130° field of view (Natus RetCam Envision). Pediatric retinal photograph (wide-field)
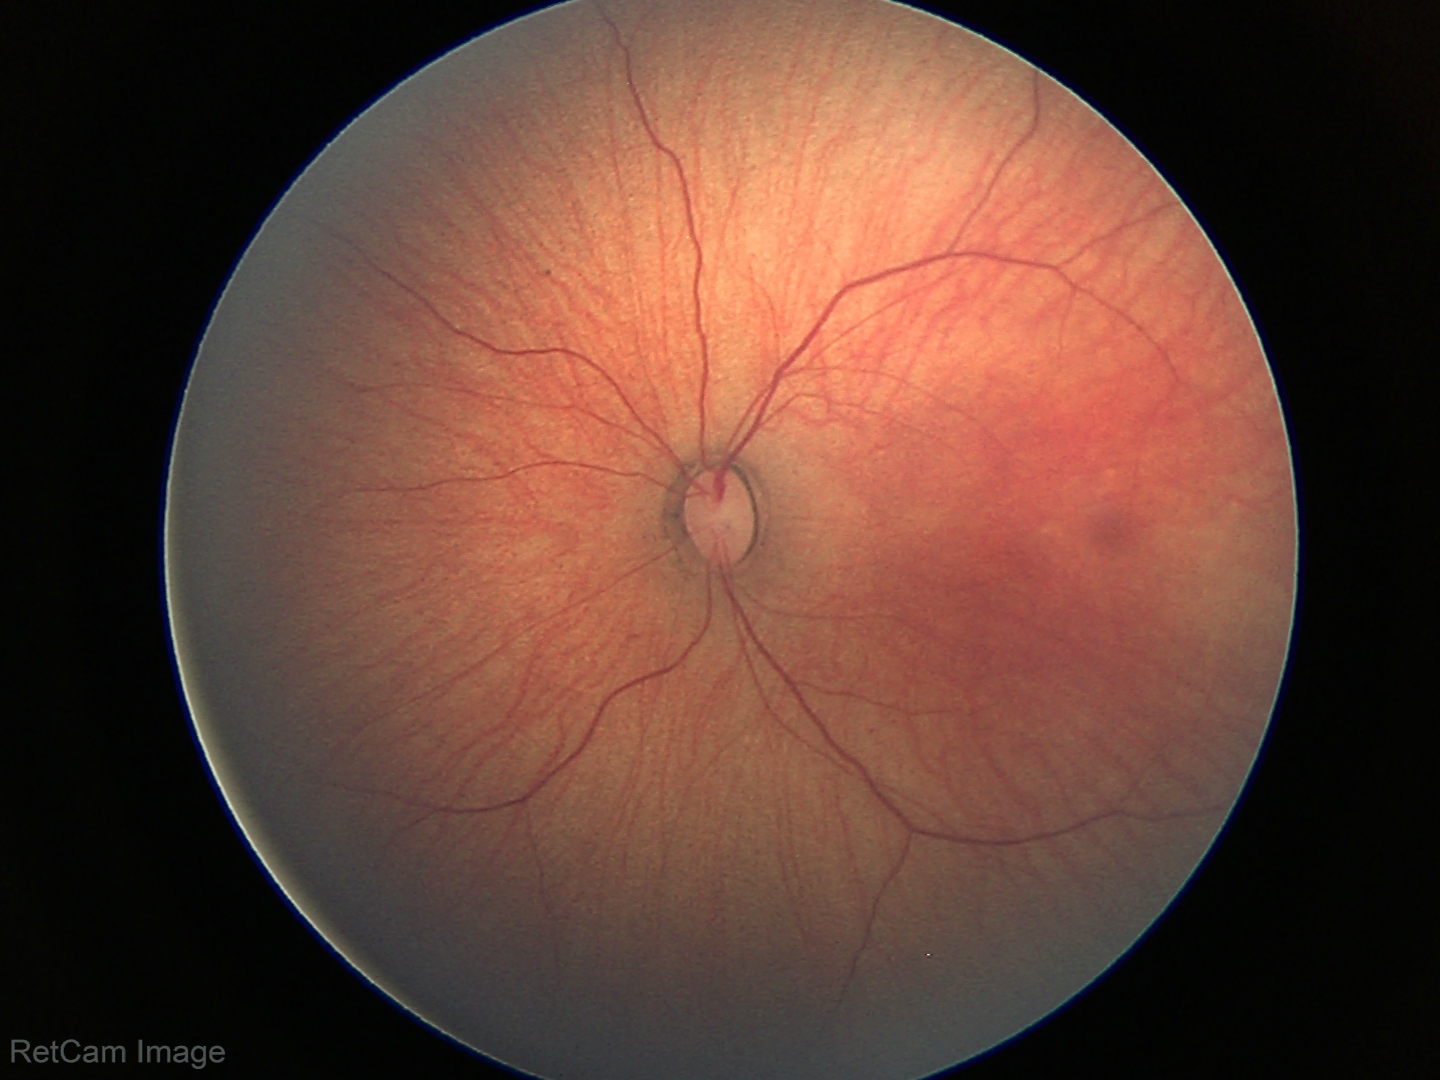

Q: What was the screening finding?
A: physiological appearance with no retinal pathology